1536 x 1152 pixels · 45° field of view · CFP.
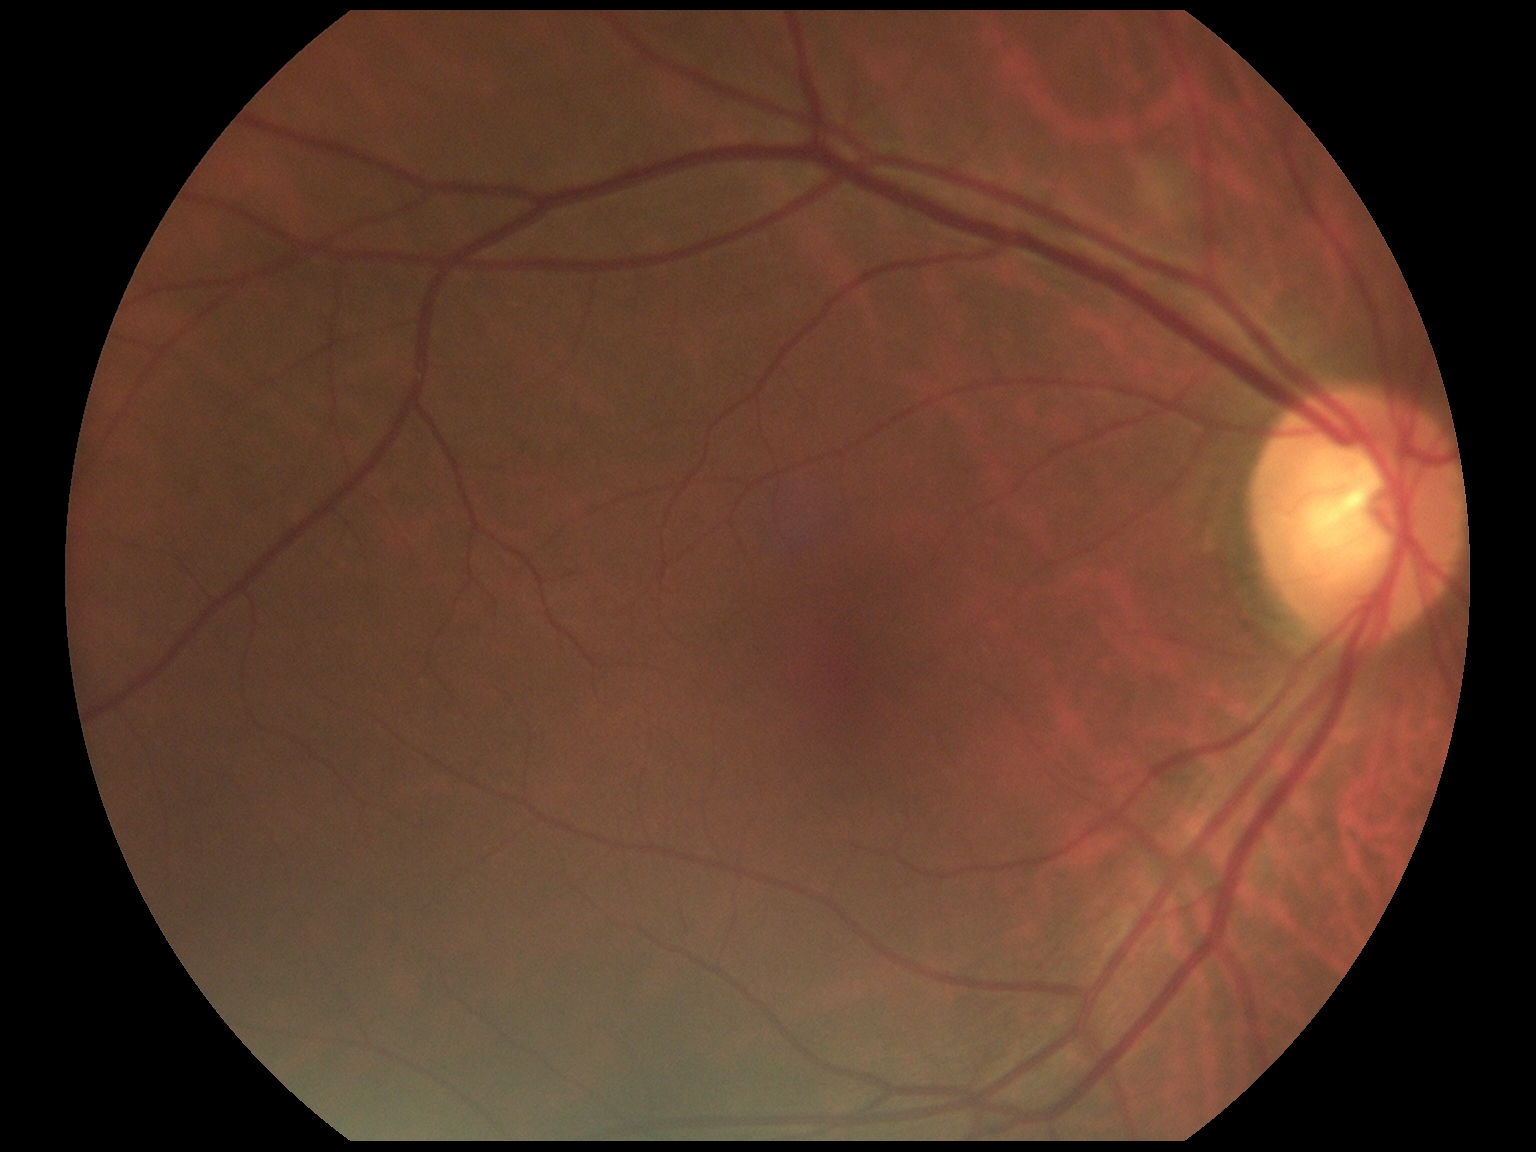 diabetic retinopathy (DR) = 0/4